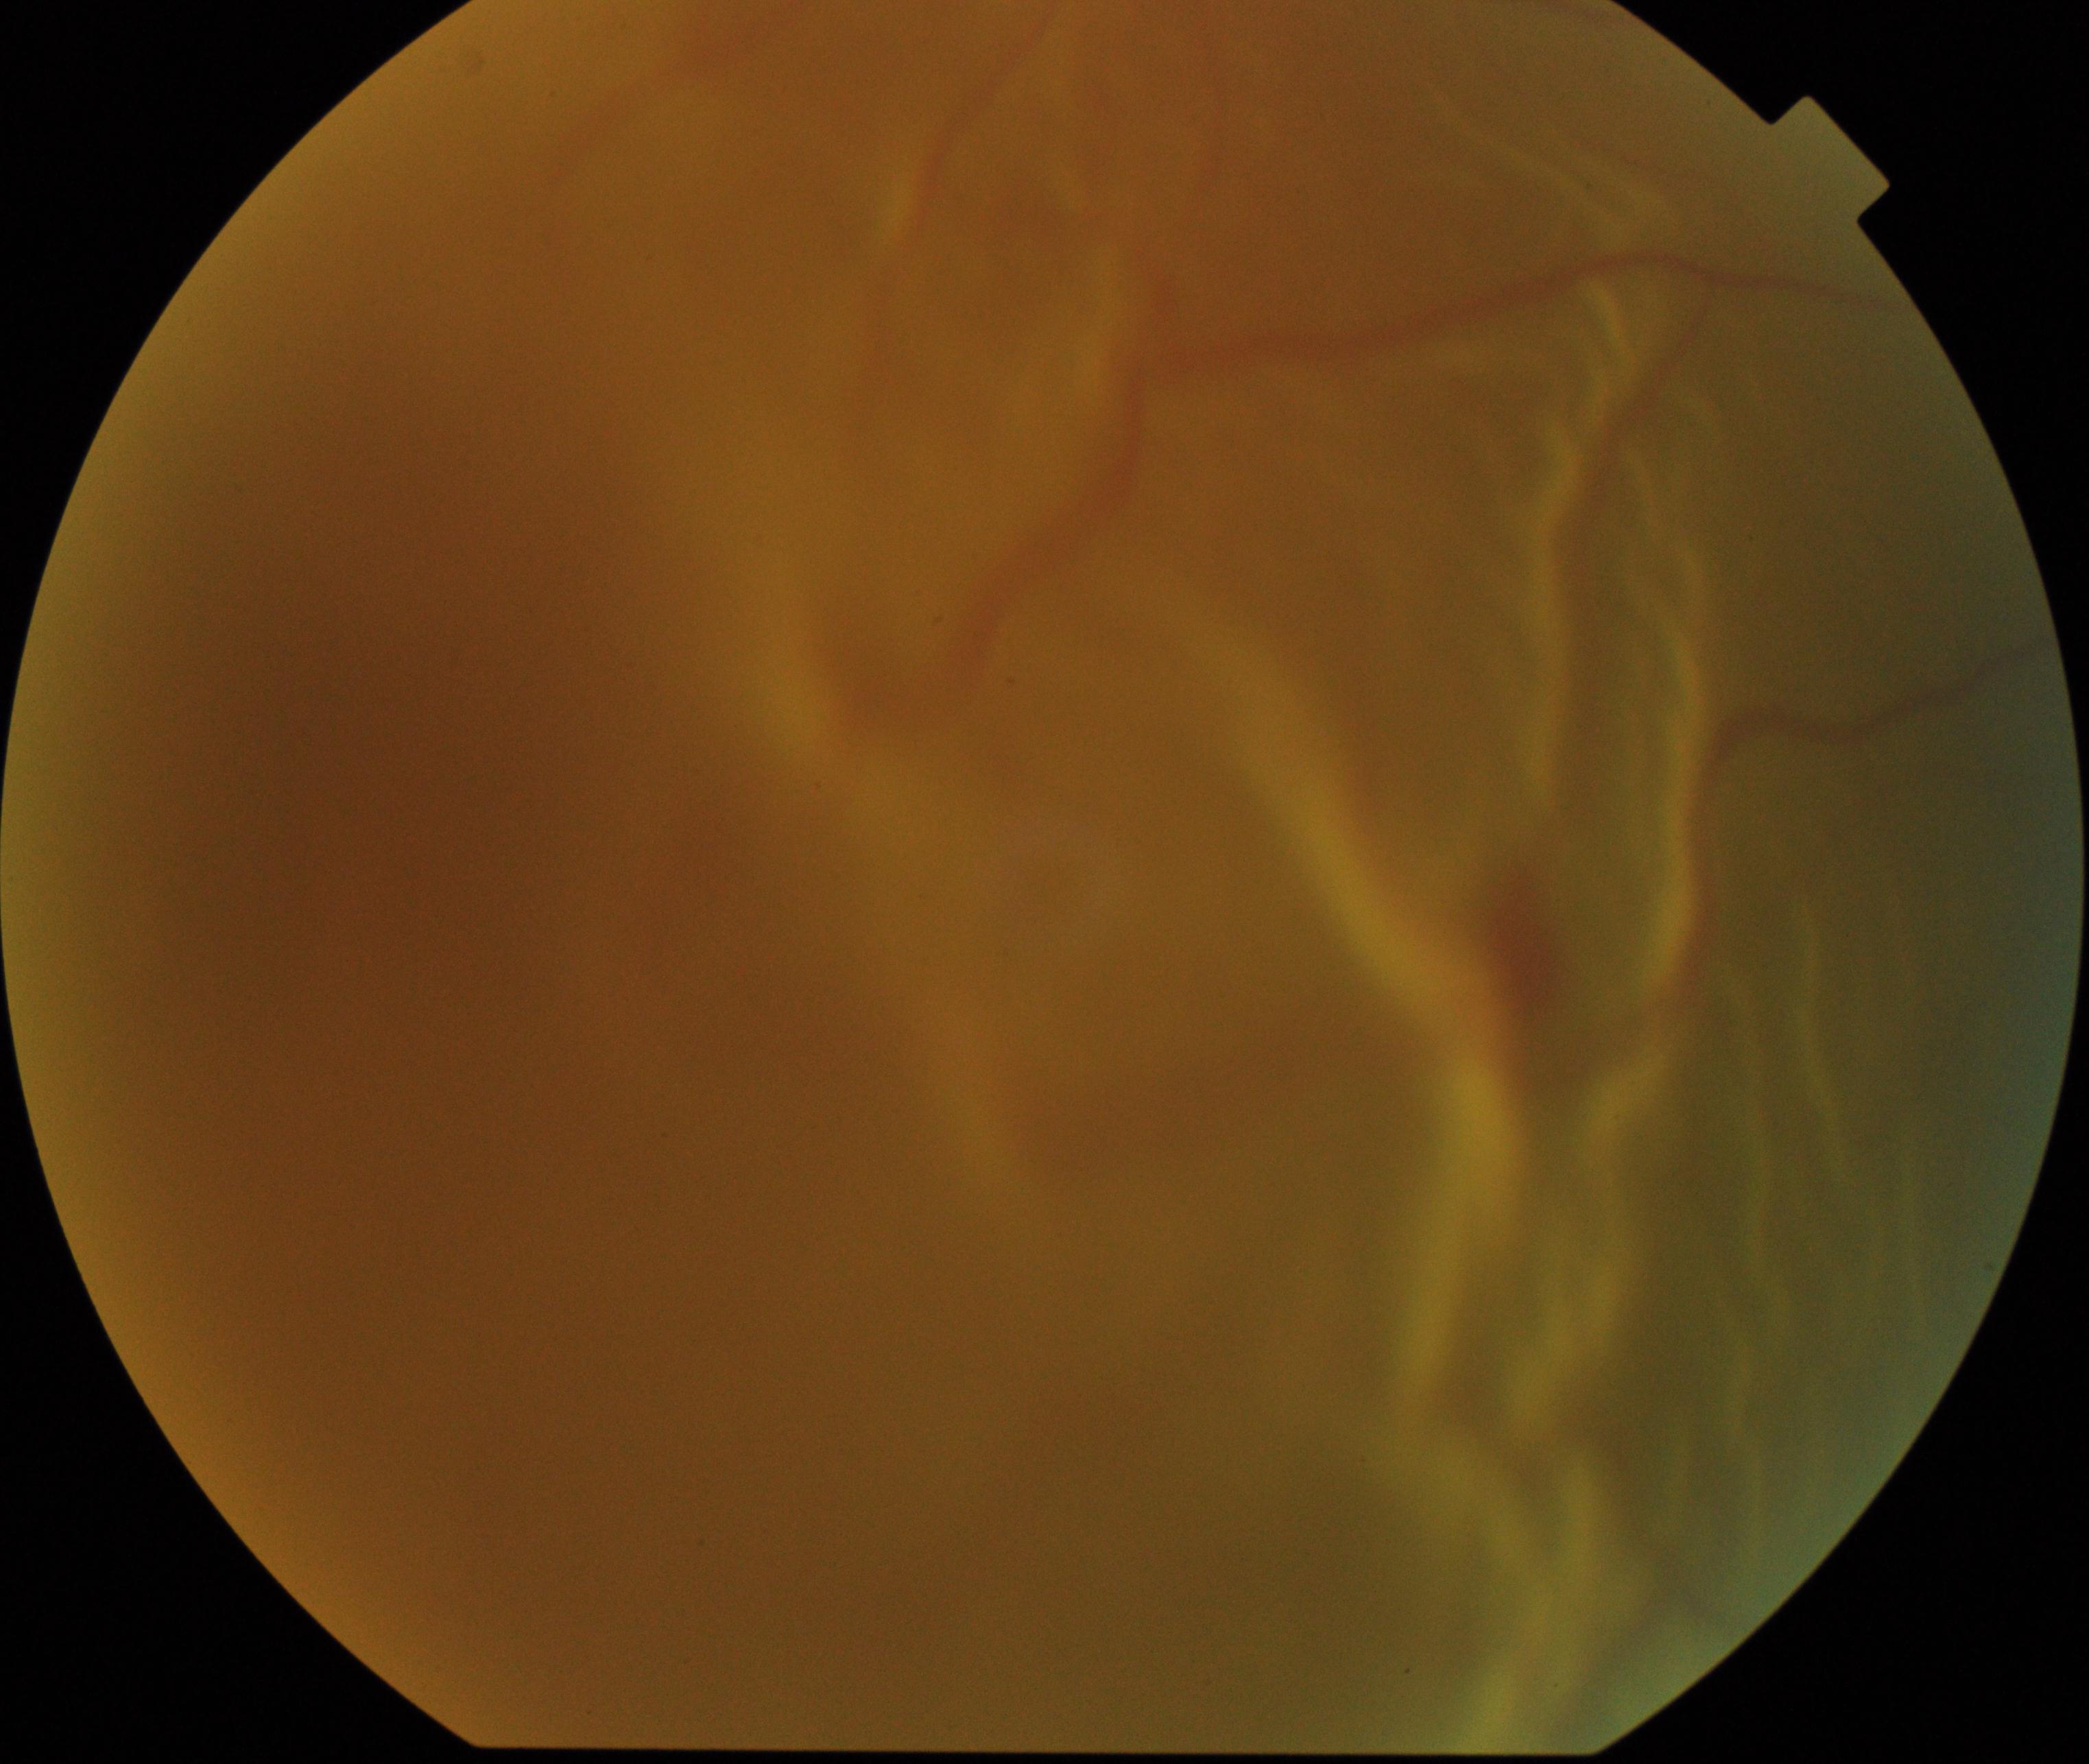
There is evidence of rhegmatogenous retinal detachment.